Wide-field fundus photograph of an infant; camera: Natus RetCam Envision (130° FOV)
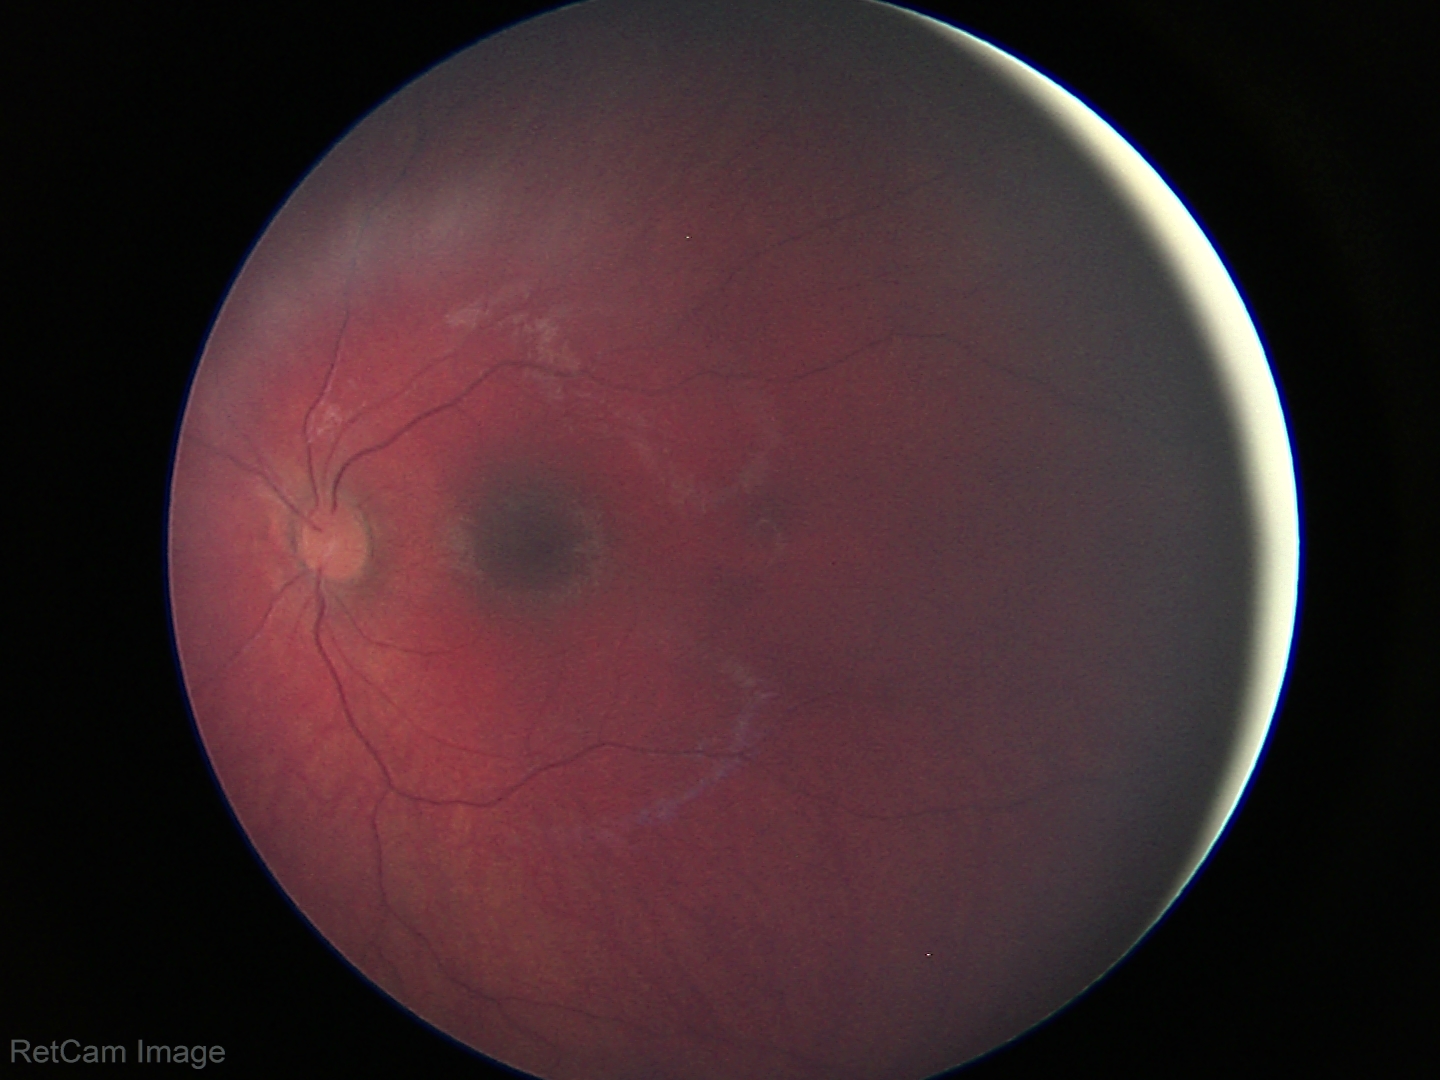

Screening examination with no abnormal retinal findings.